Acquired with a Nidek AFC-330; optic disc region crop — 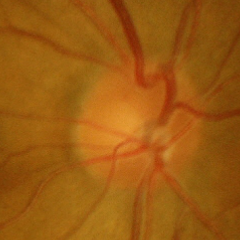 The image shows early glaucomatous optic neuropathy.